Wide-field fundus image from infant ROP screening.
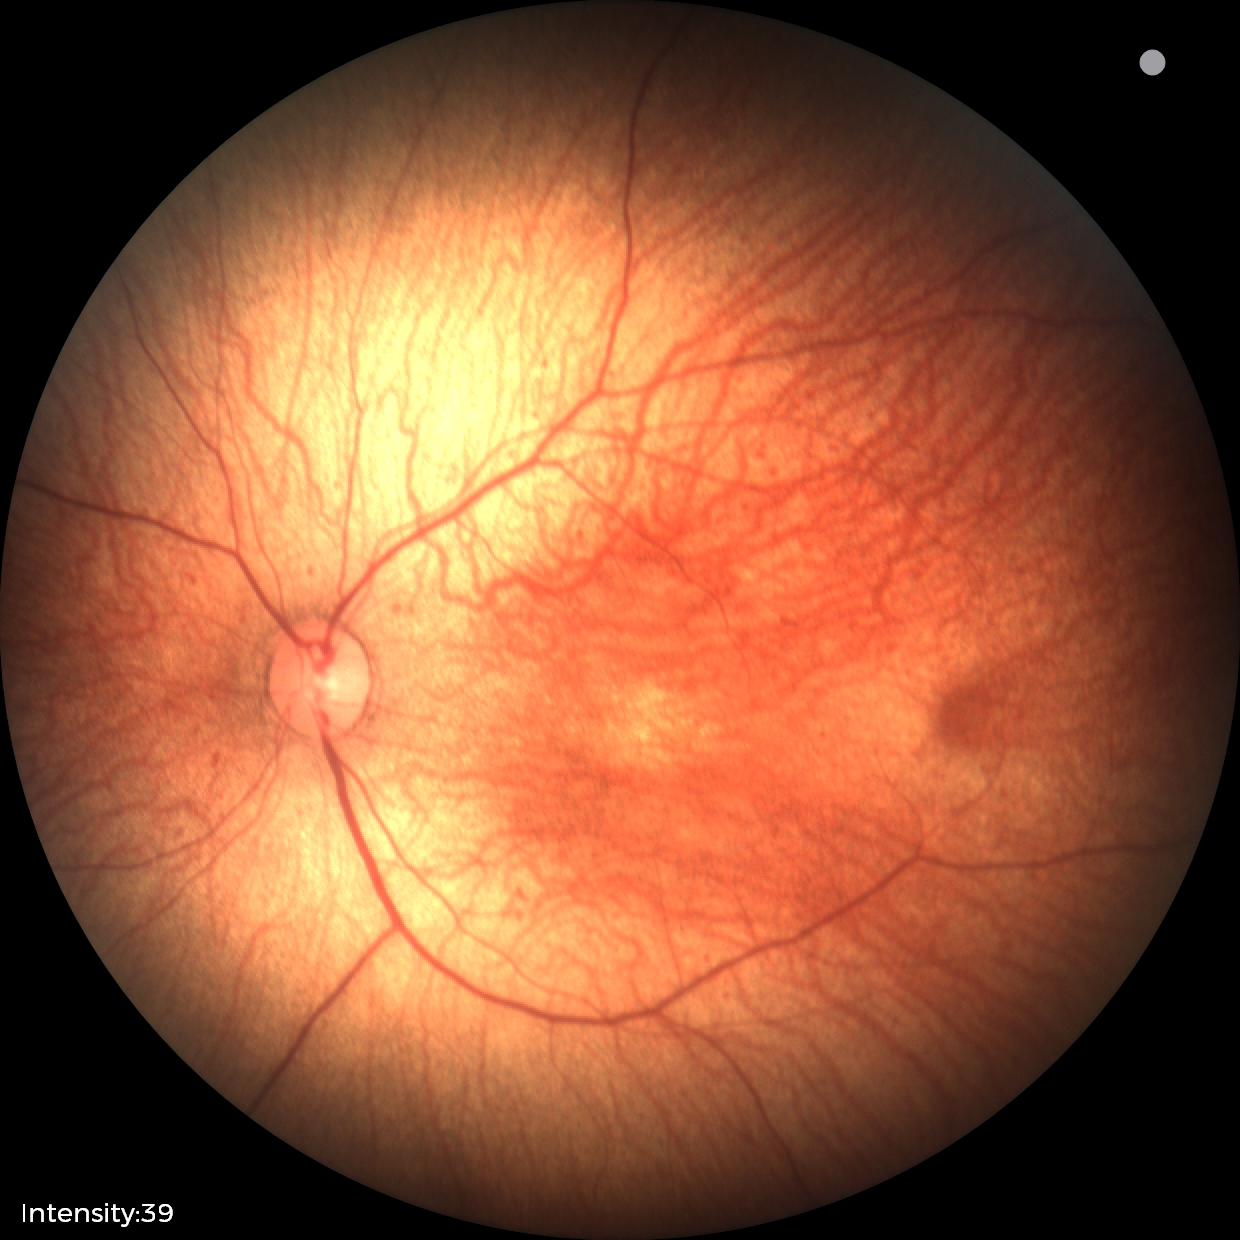
Screening: physiological retinal finding.